1240 x 1240 pixels · Phoenix ICON wide-field infant fundus image: 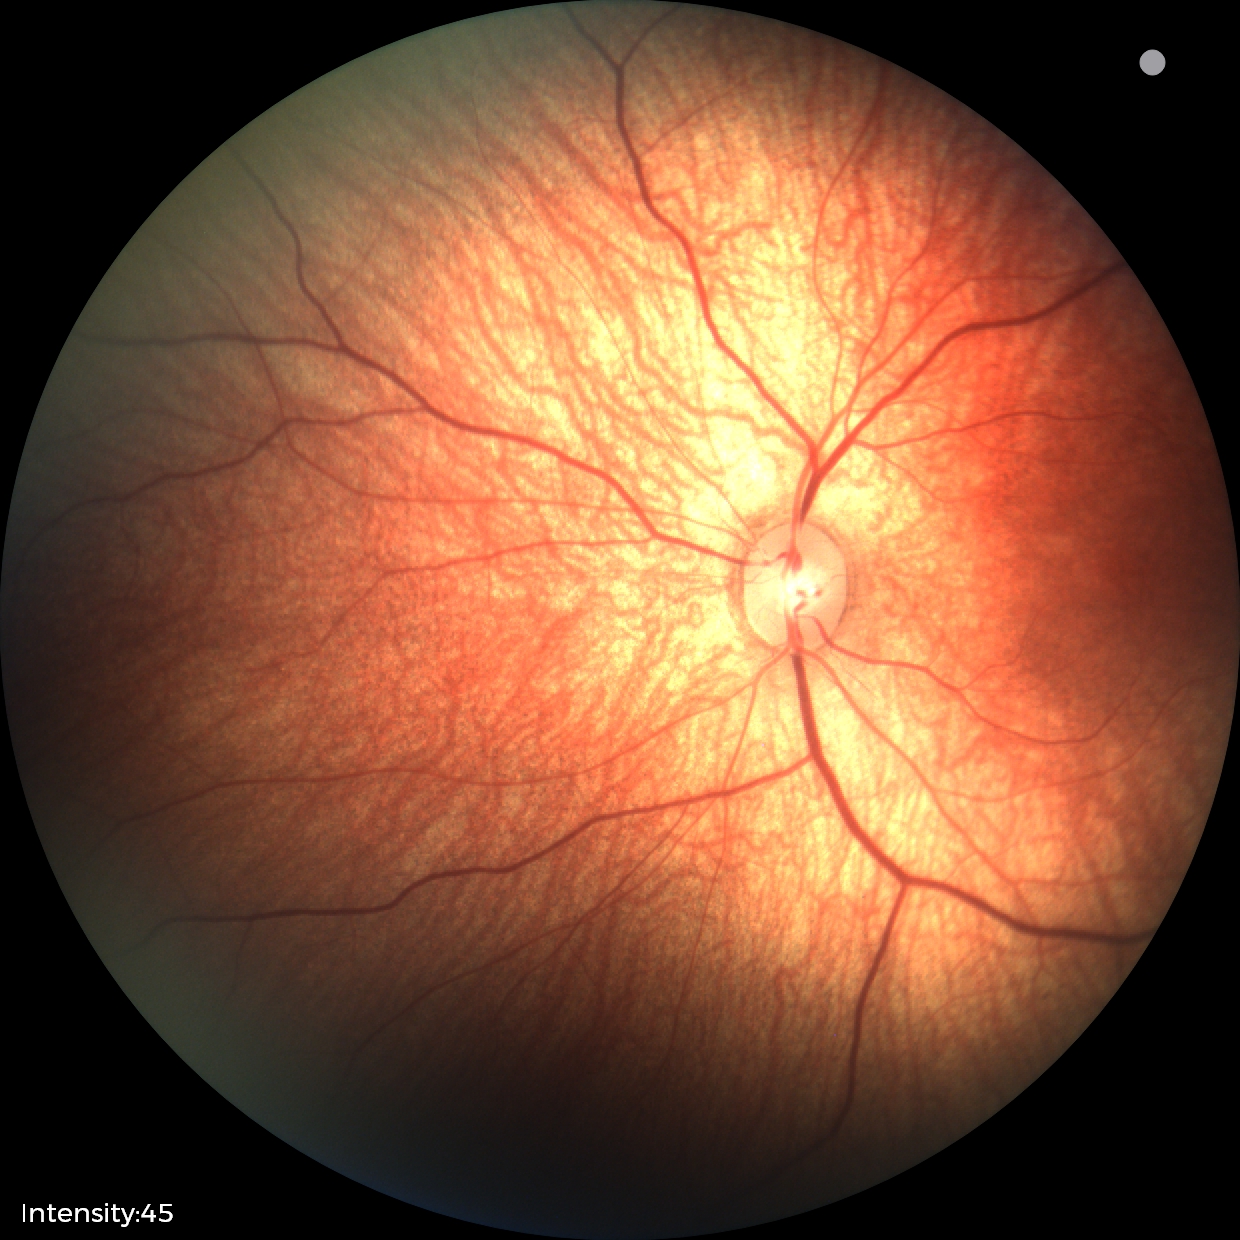 No retinal pathology identified on screening.